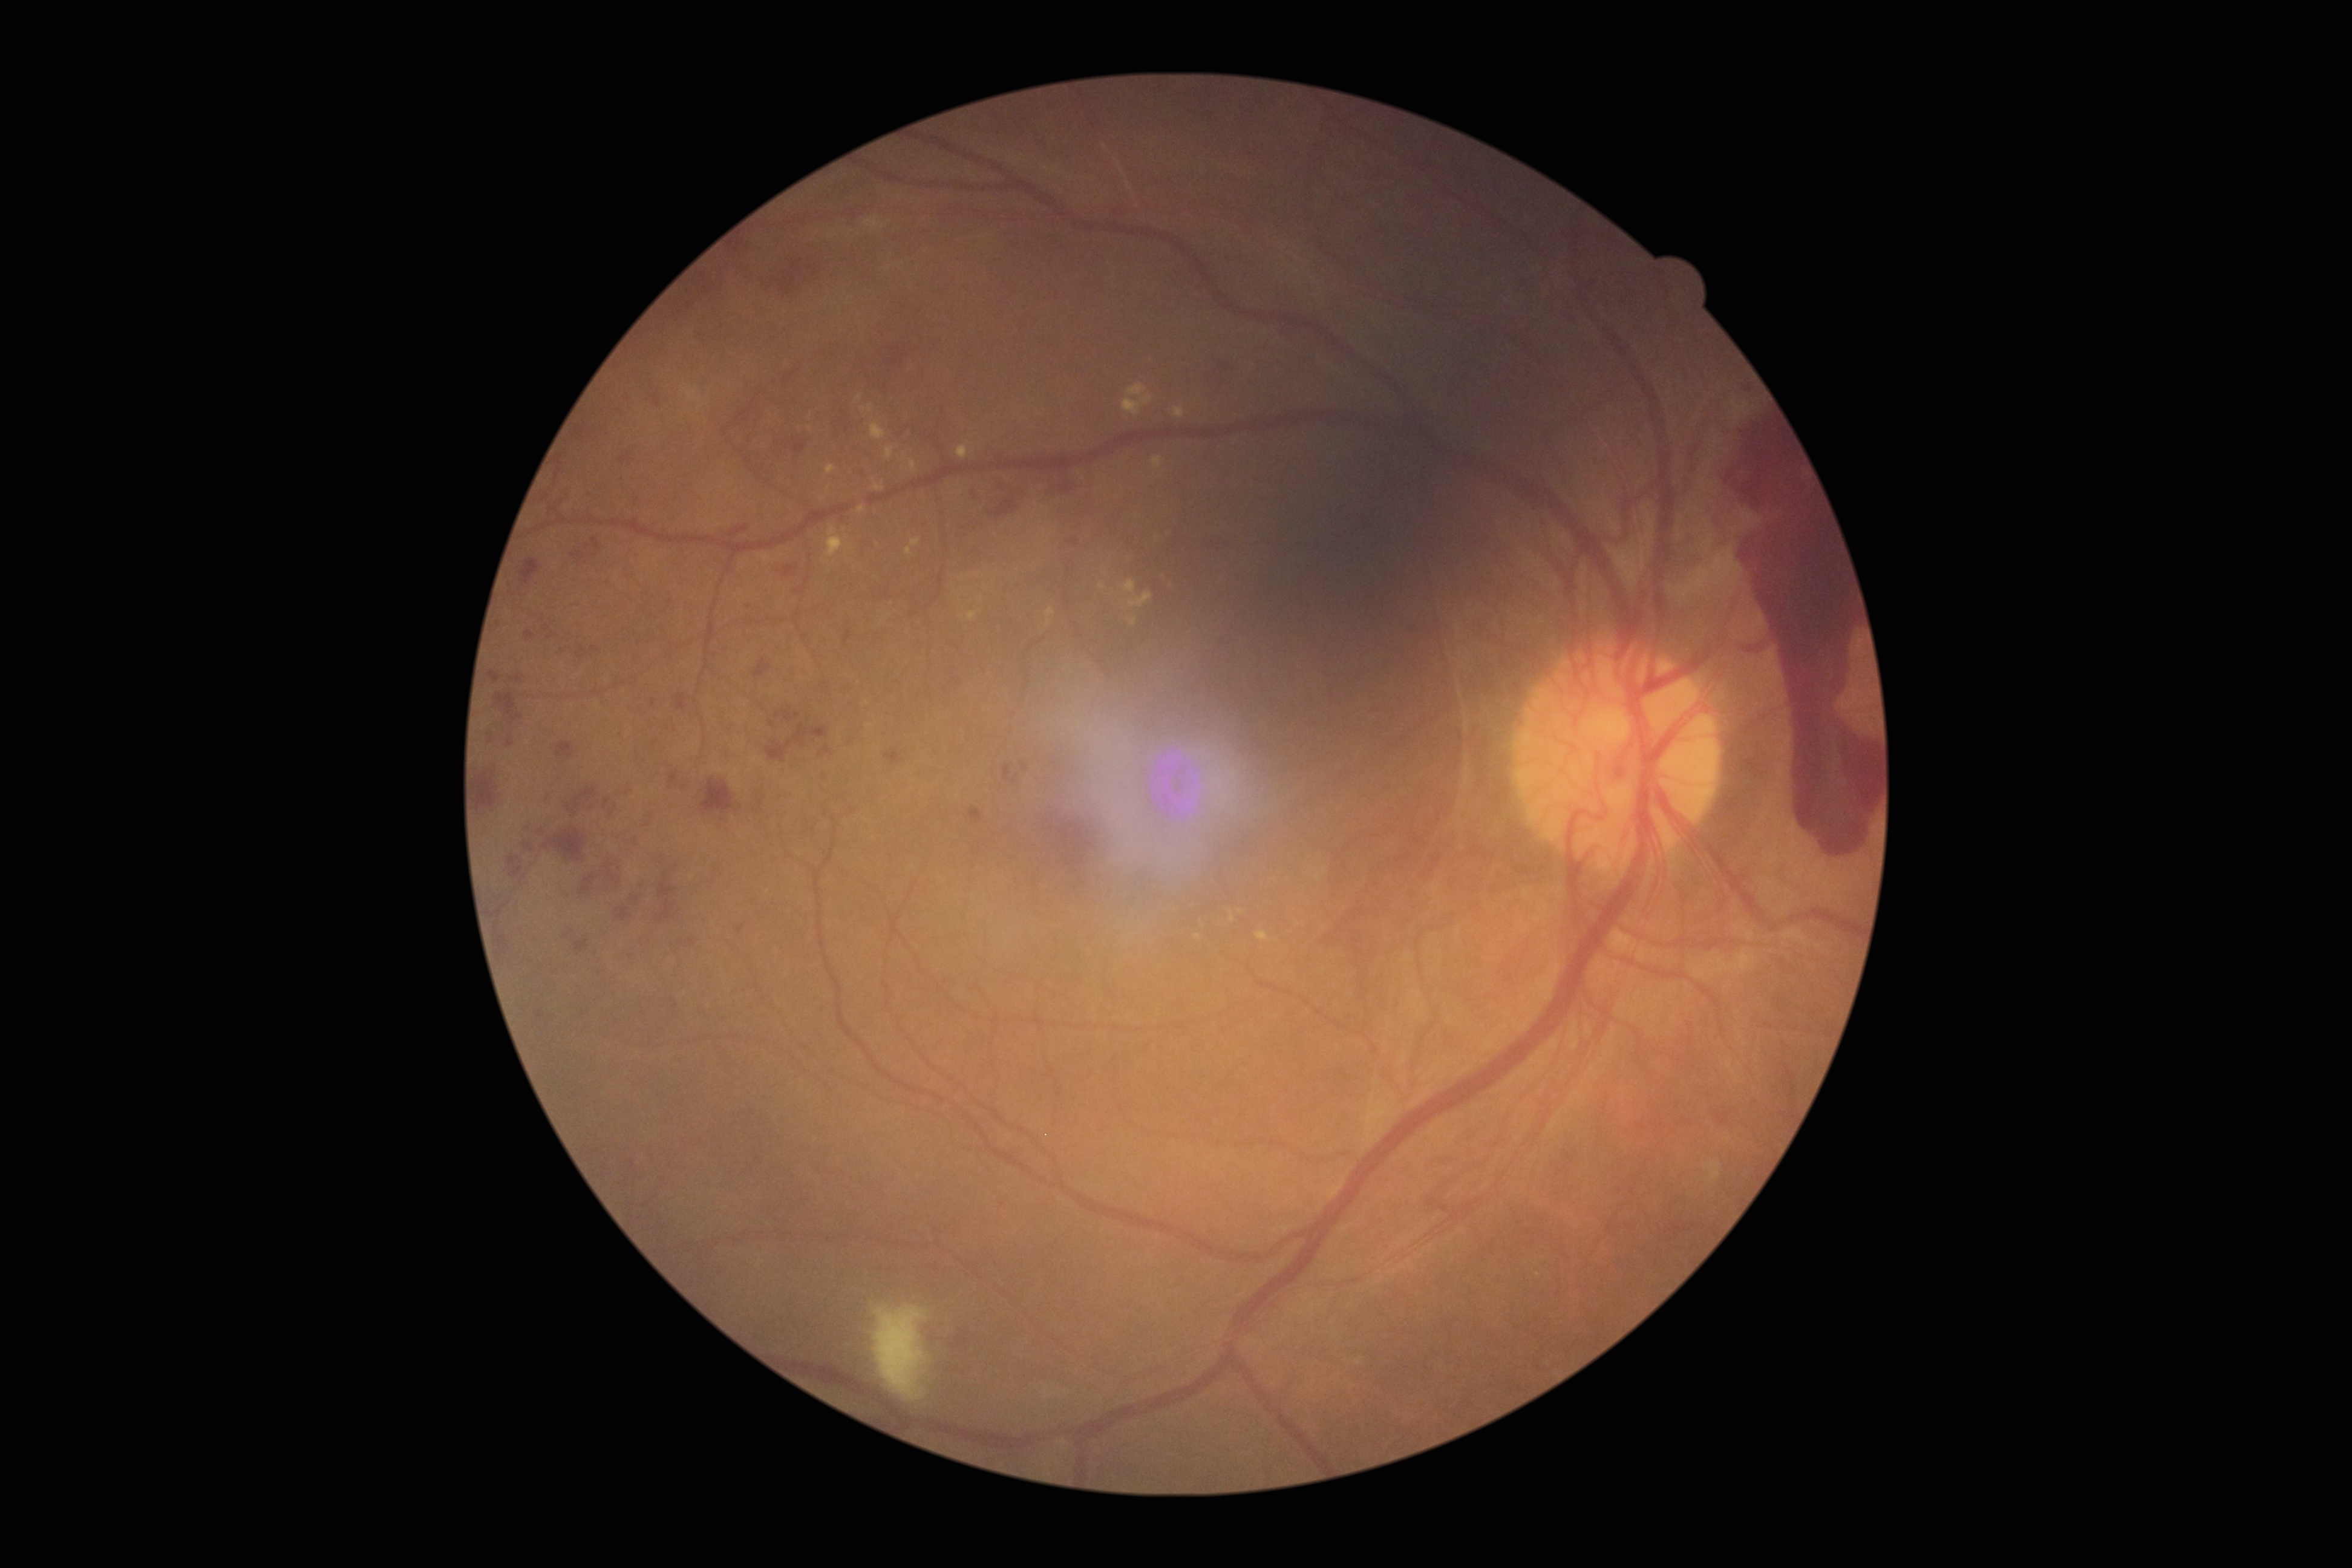
diabetic retinopathy (DR): 4/4.